CFP
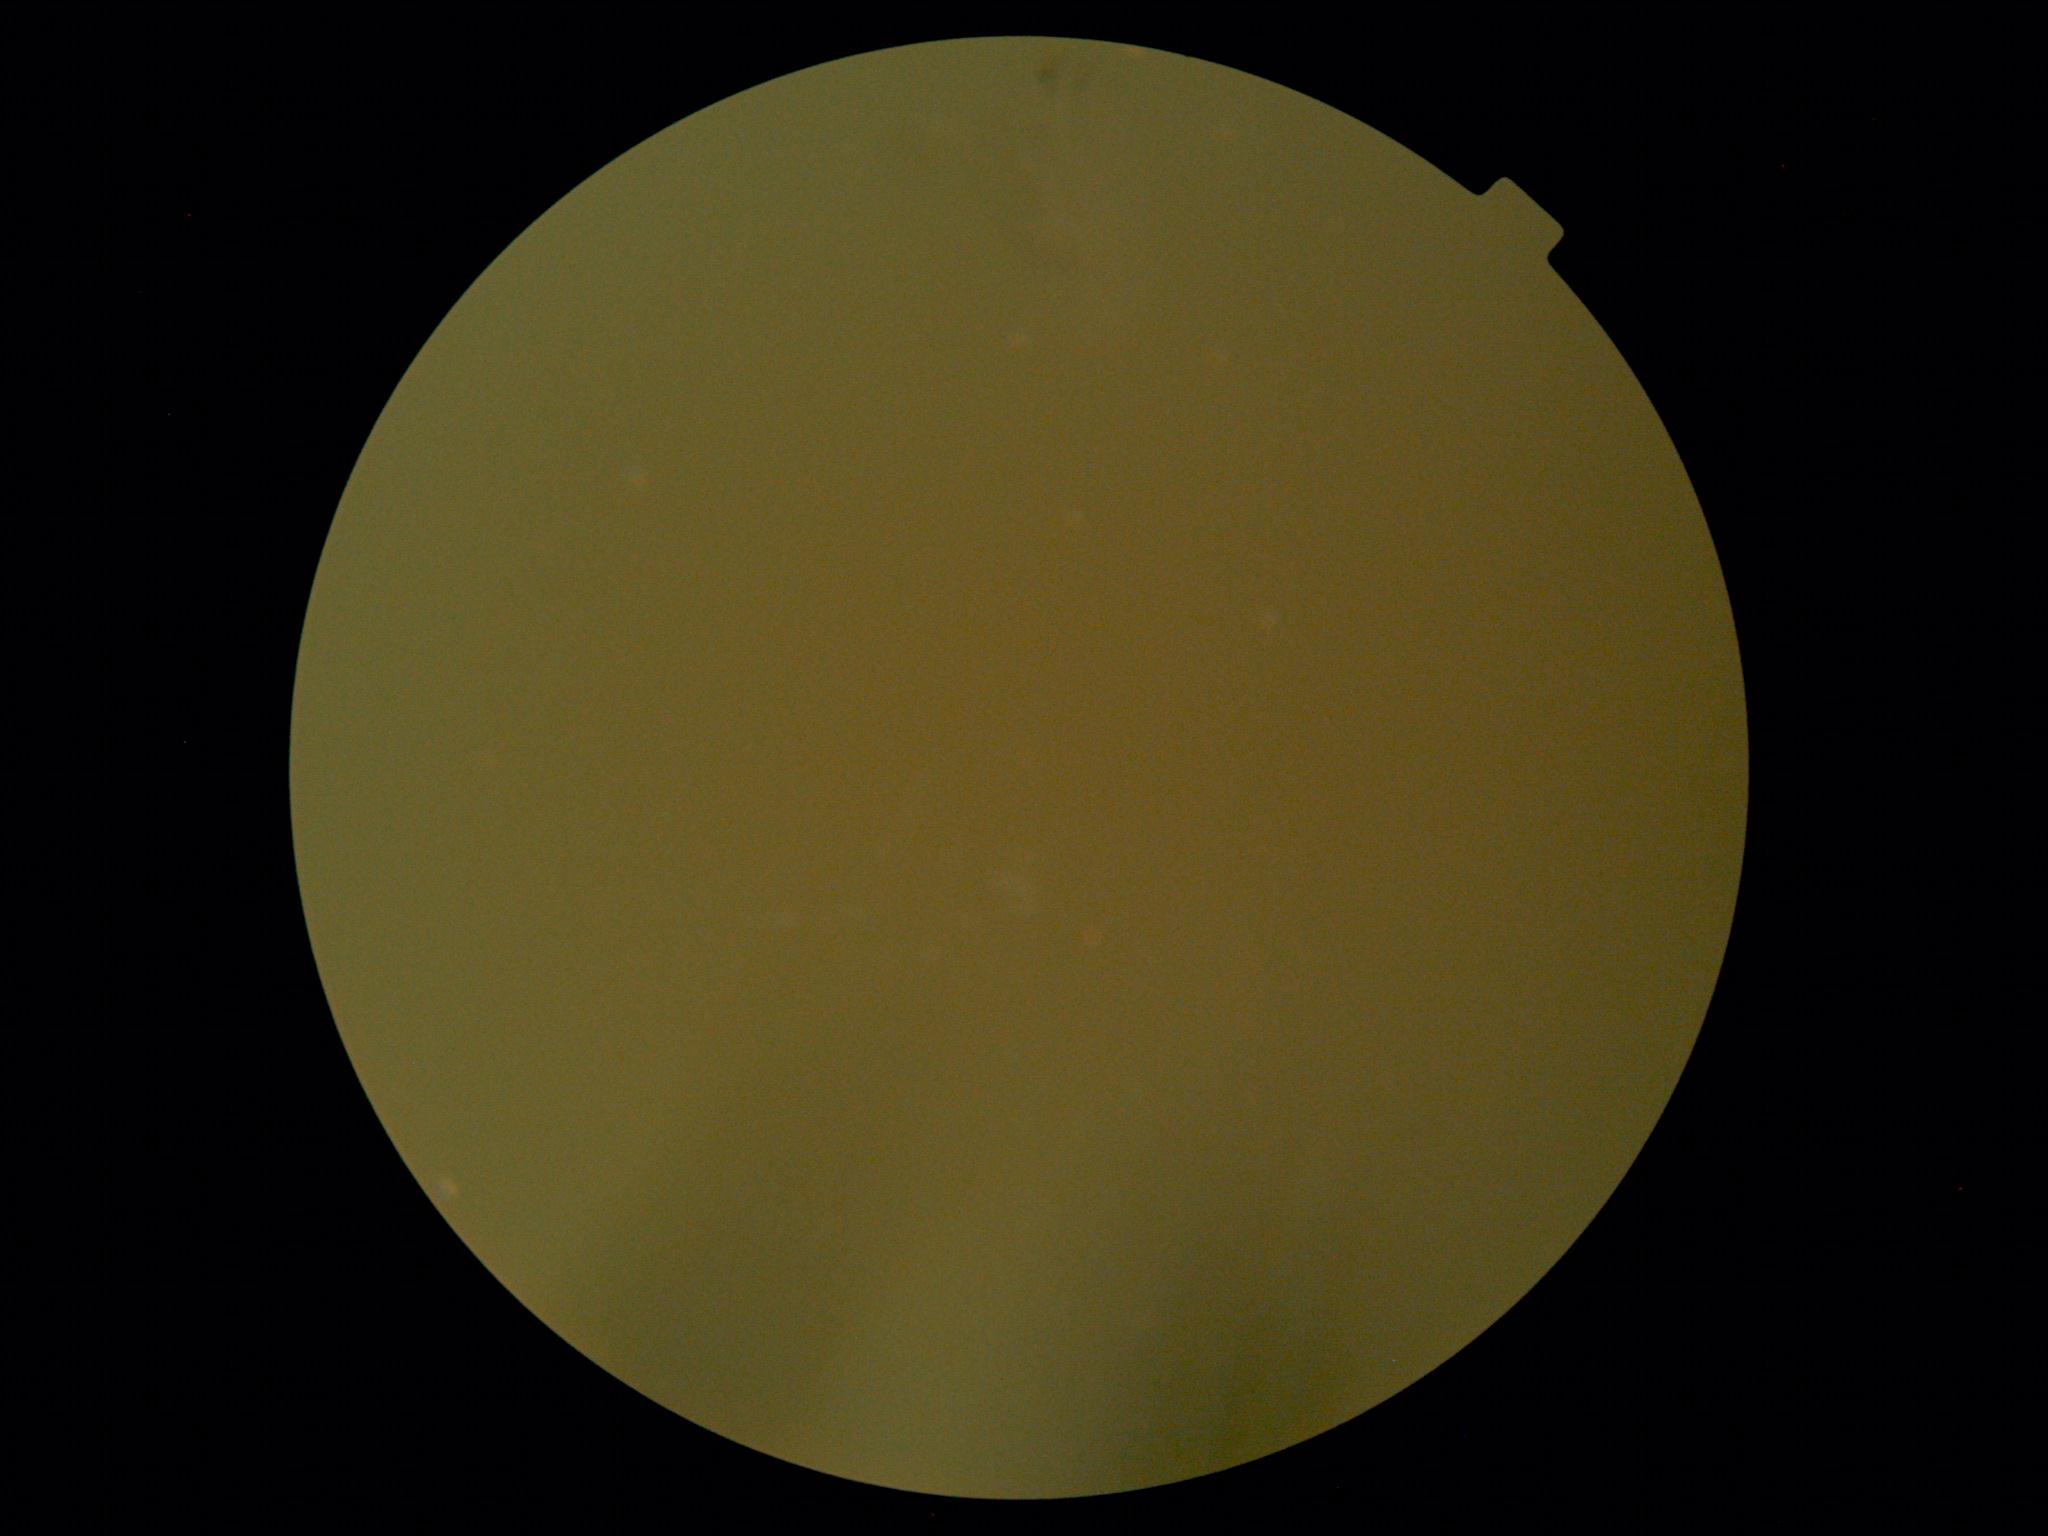 image quality: insufficient for DR assessment | DR severity: ungradable.